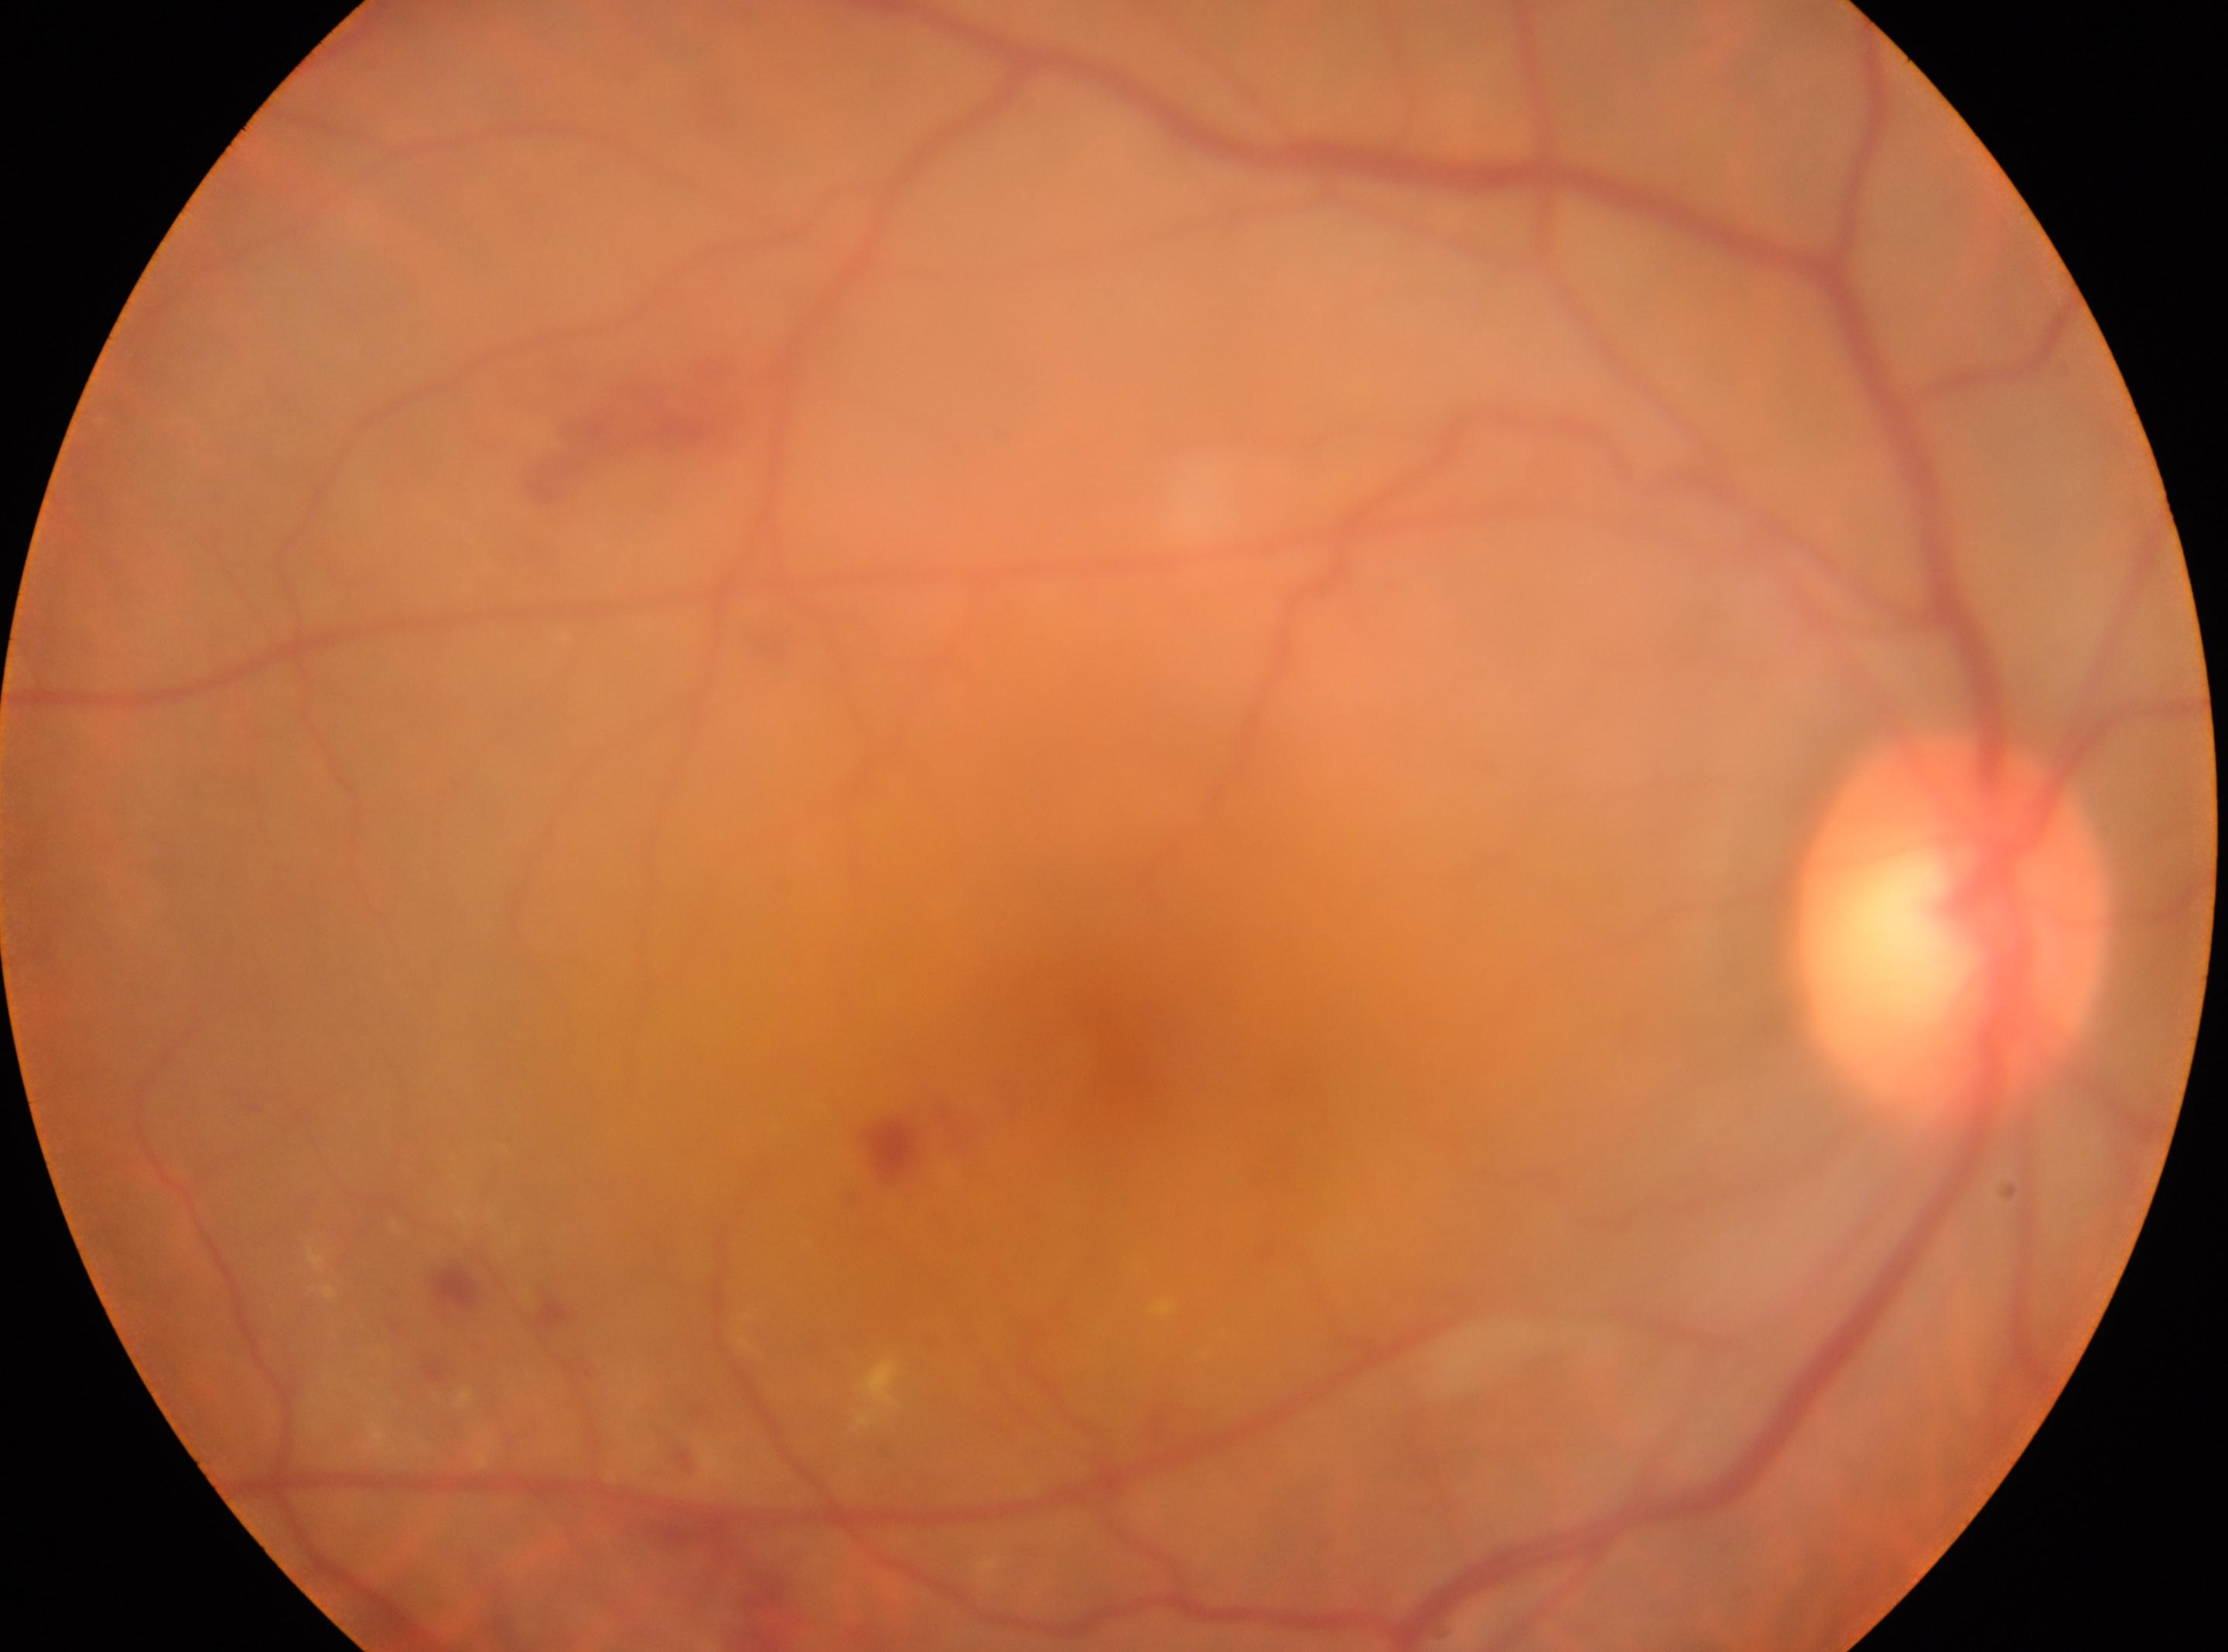   eye: OD
  fovea: (1105,1055)
  dr_category: non-proliferative diabetic retinopathy
  optic_disc: (1951,930)
  dr_grade: moderate non-proliferative diabetic retinopathy (grade 2)